NIDEK AFC-230.
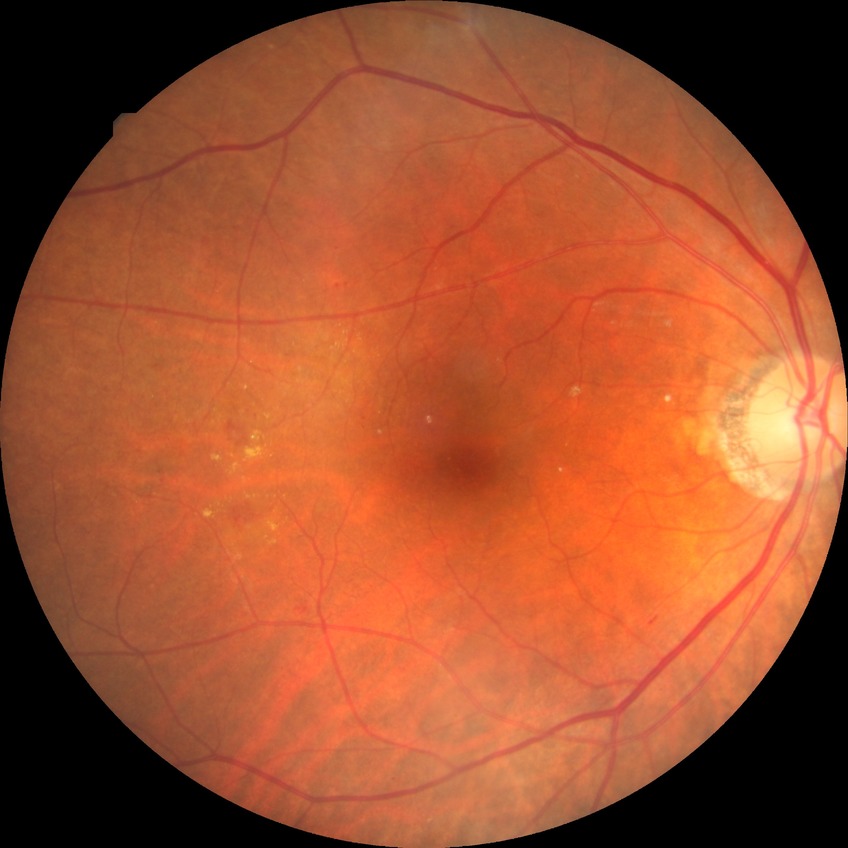 Diabetic retinopathy (DR): SDR (simple diabetic retinopathy).